45-degree field of view
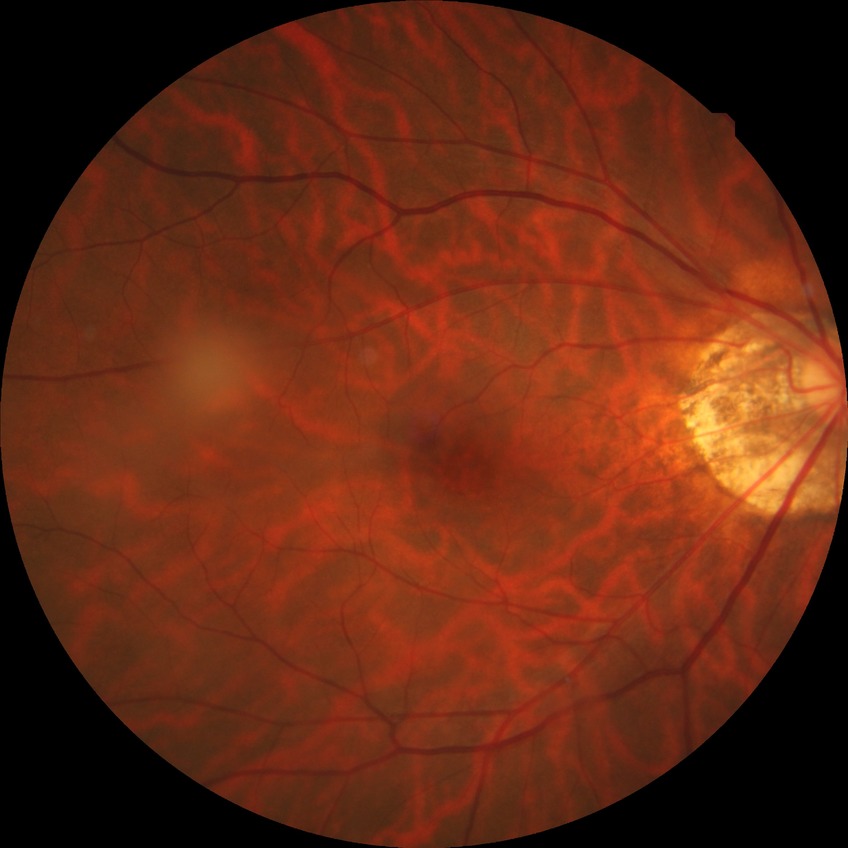 modified Davis grade = NDR.